Modified Davis classification:
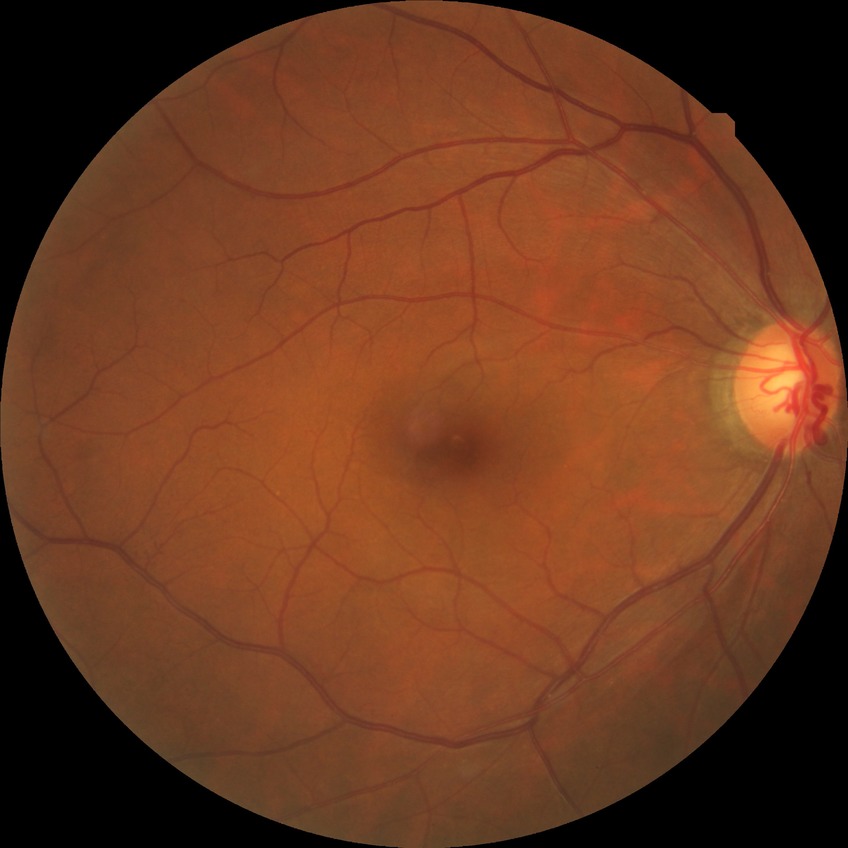
* diabetic retinopathy (DR) — no diabetic retinopathy (NDR)